Color fundus image; 50-degree field of view
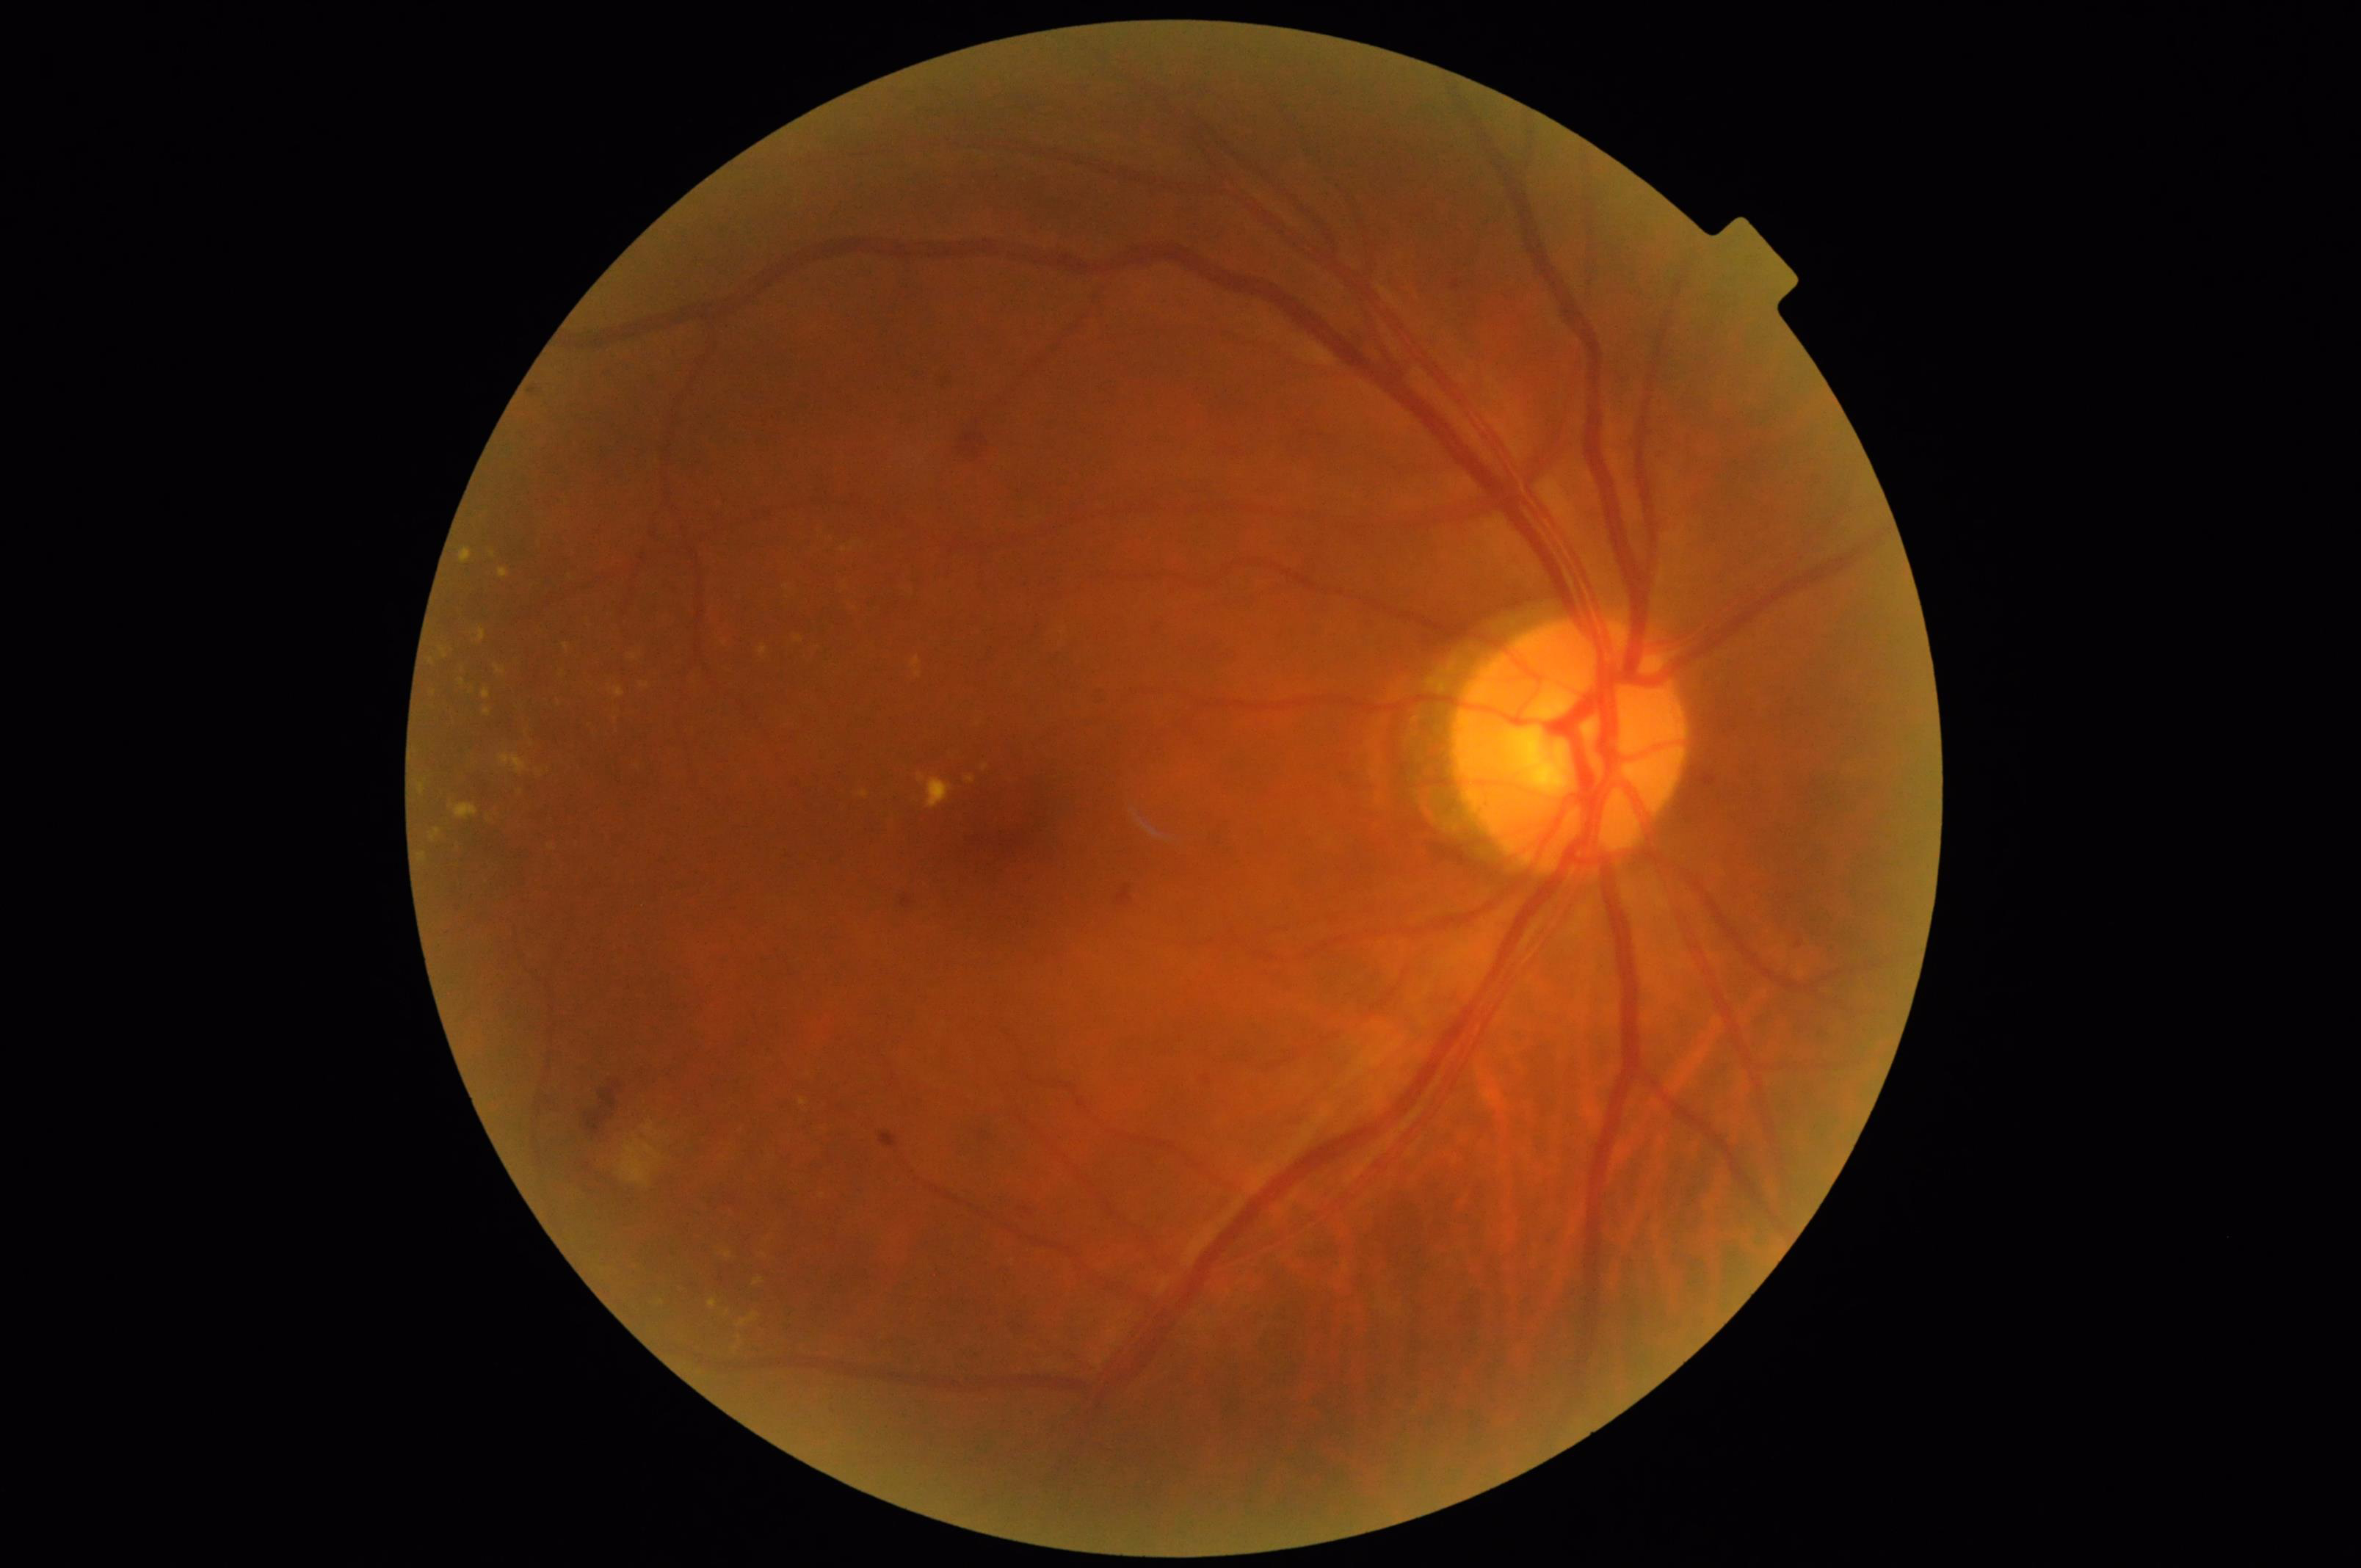
Quality assessment:
- illumination/color: adequate
- overall: adequate
- sharpness: in focus
- contrast: good